2352x1568 — 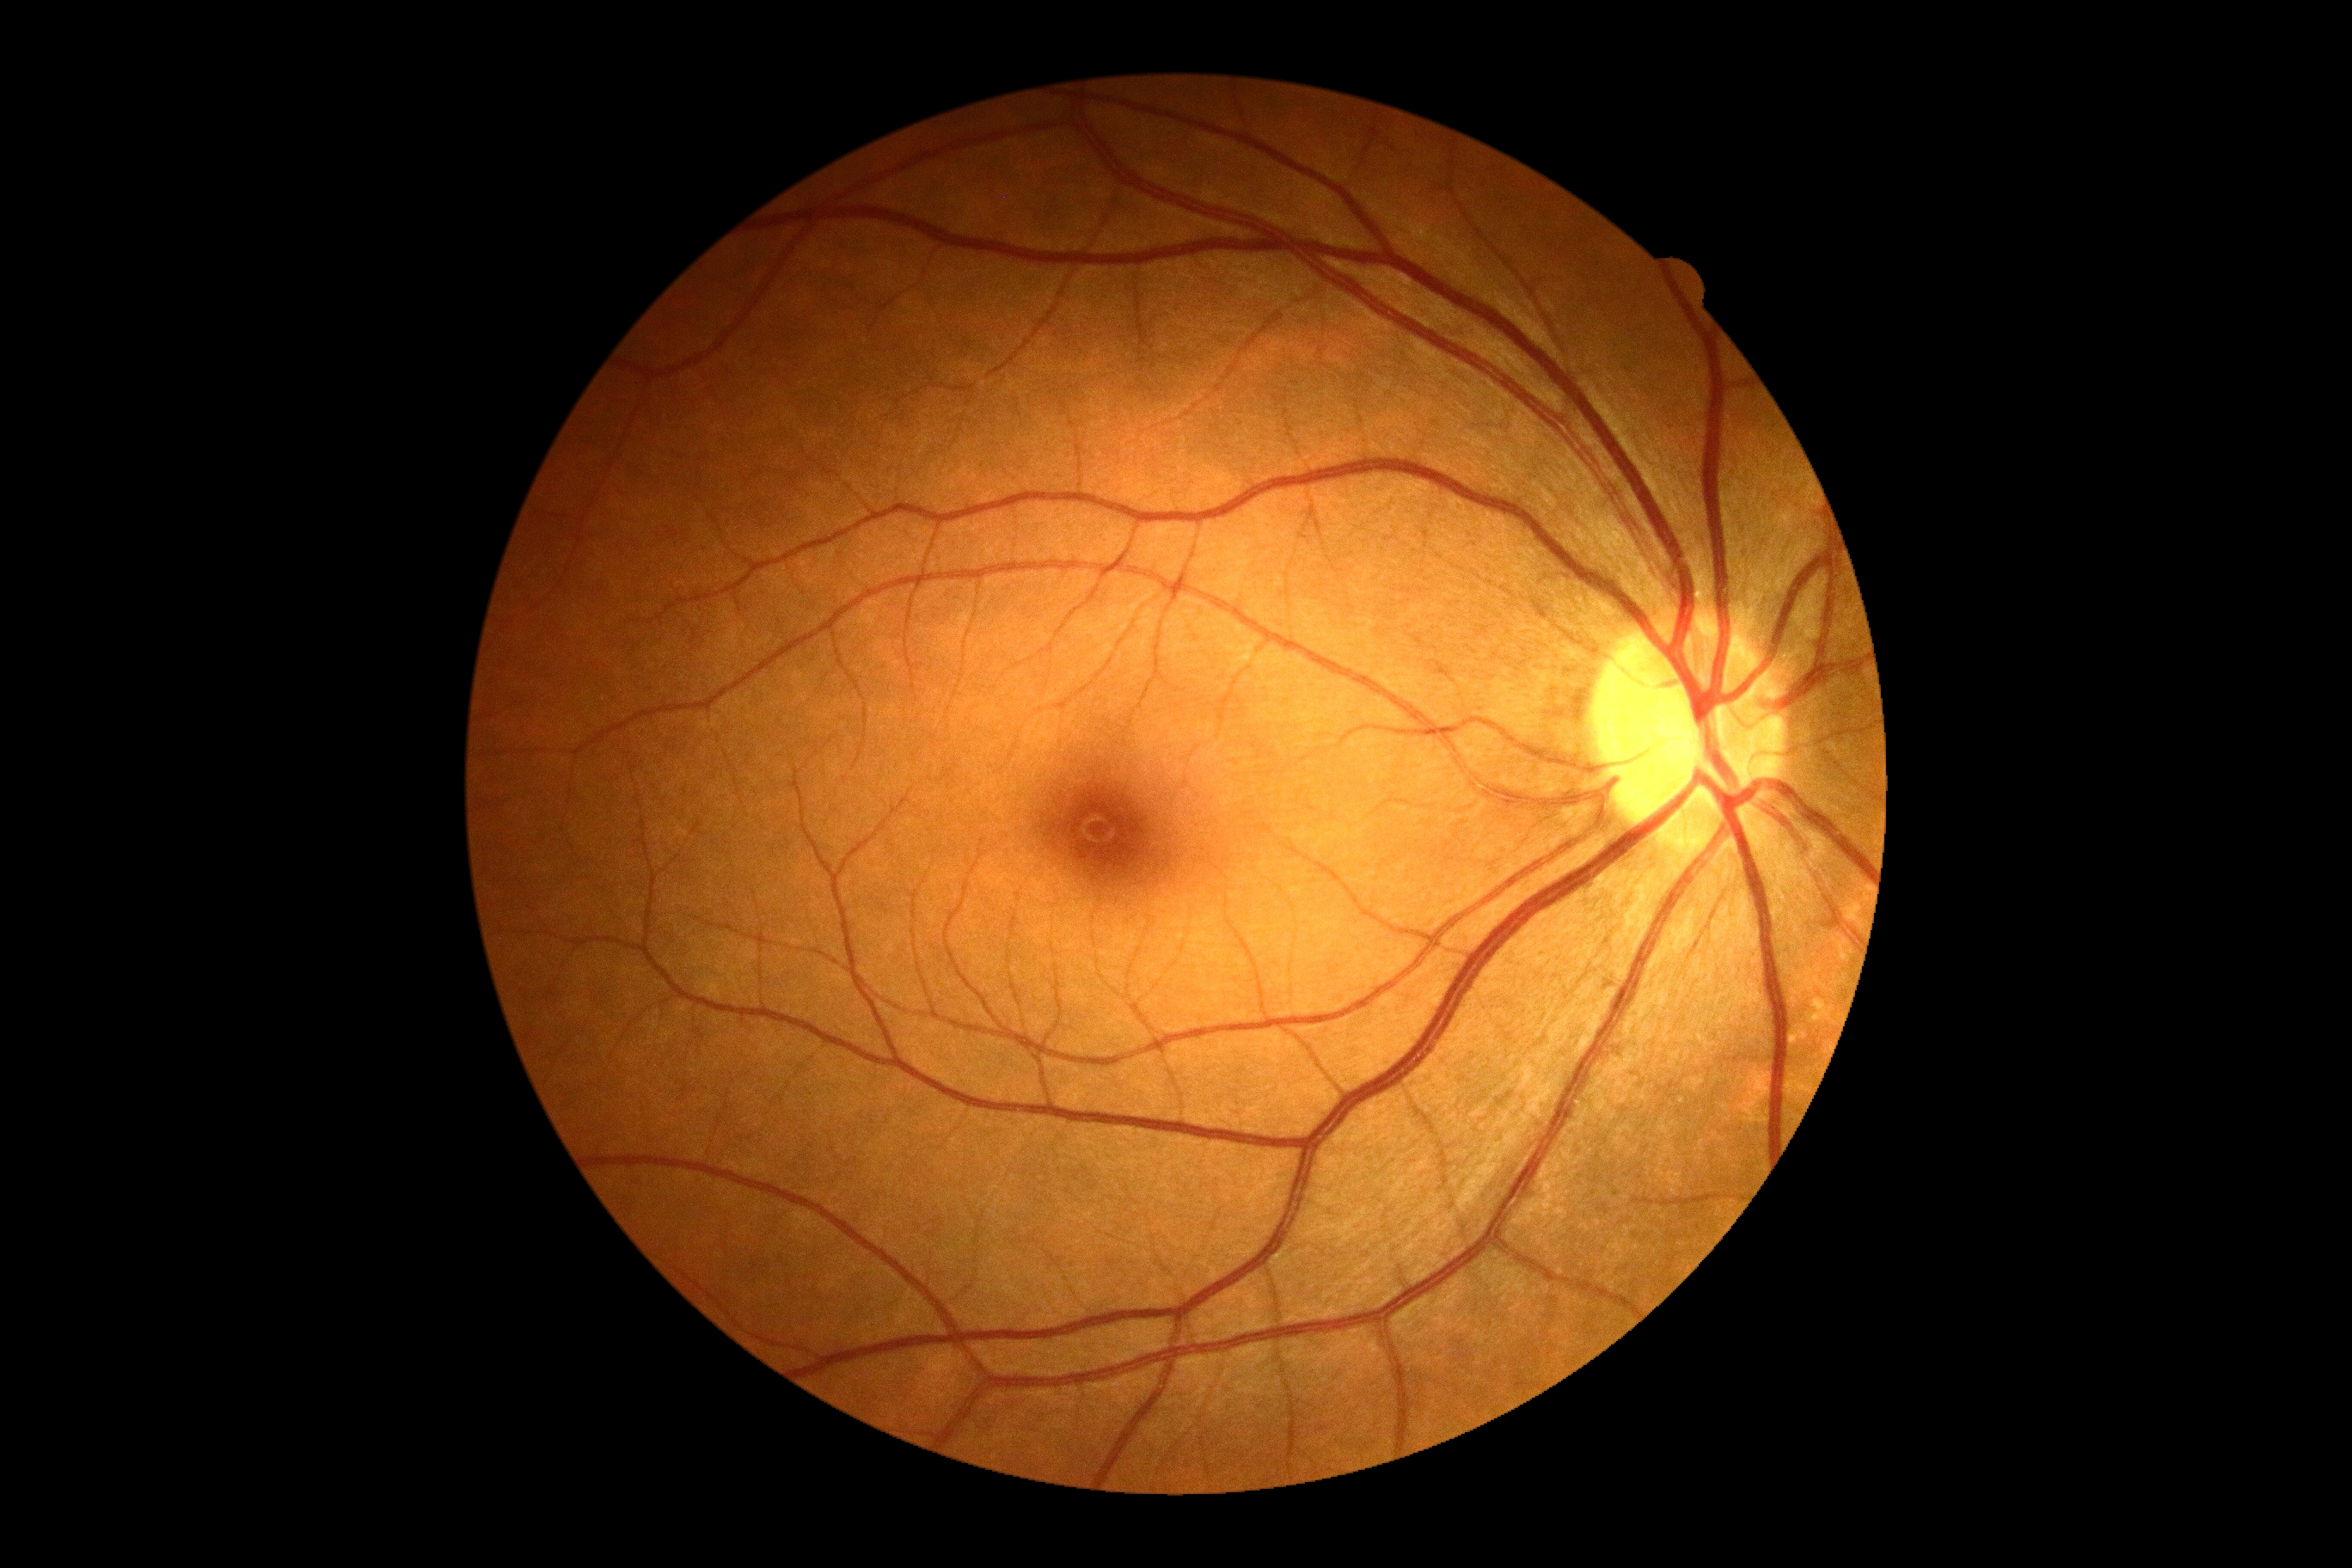

Diabetic retinopathy (DR) is grade 0.